FOV: 45 degrees:
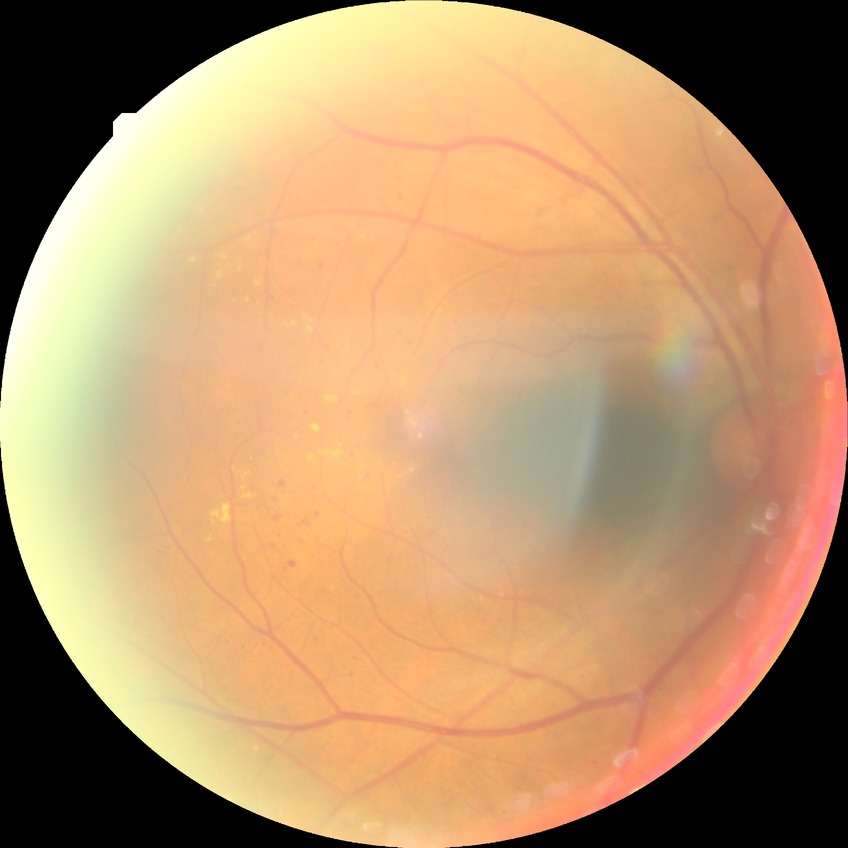
Retinopathy stage: pre-proliferative diabetic retinopathy.